CFP · pachymetry 496 µm · 2212 x 1661 pixels · axial length: 24.17 mm · captured on a Topcon TRC-NW400 fundus camera · 60 years old · refraction: +0.25 -1.5 x 160.
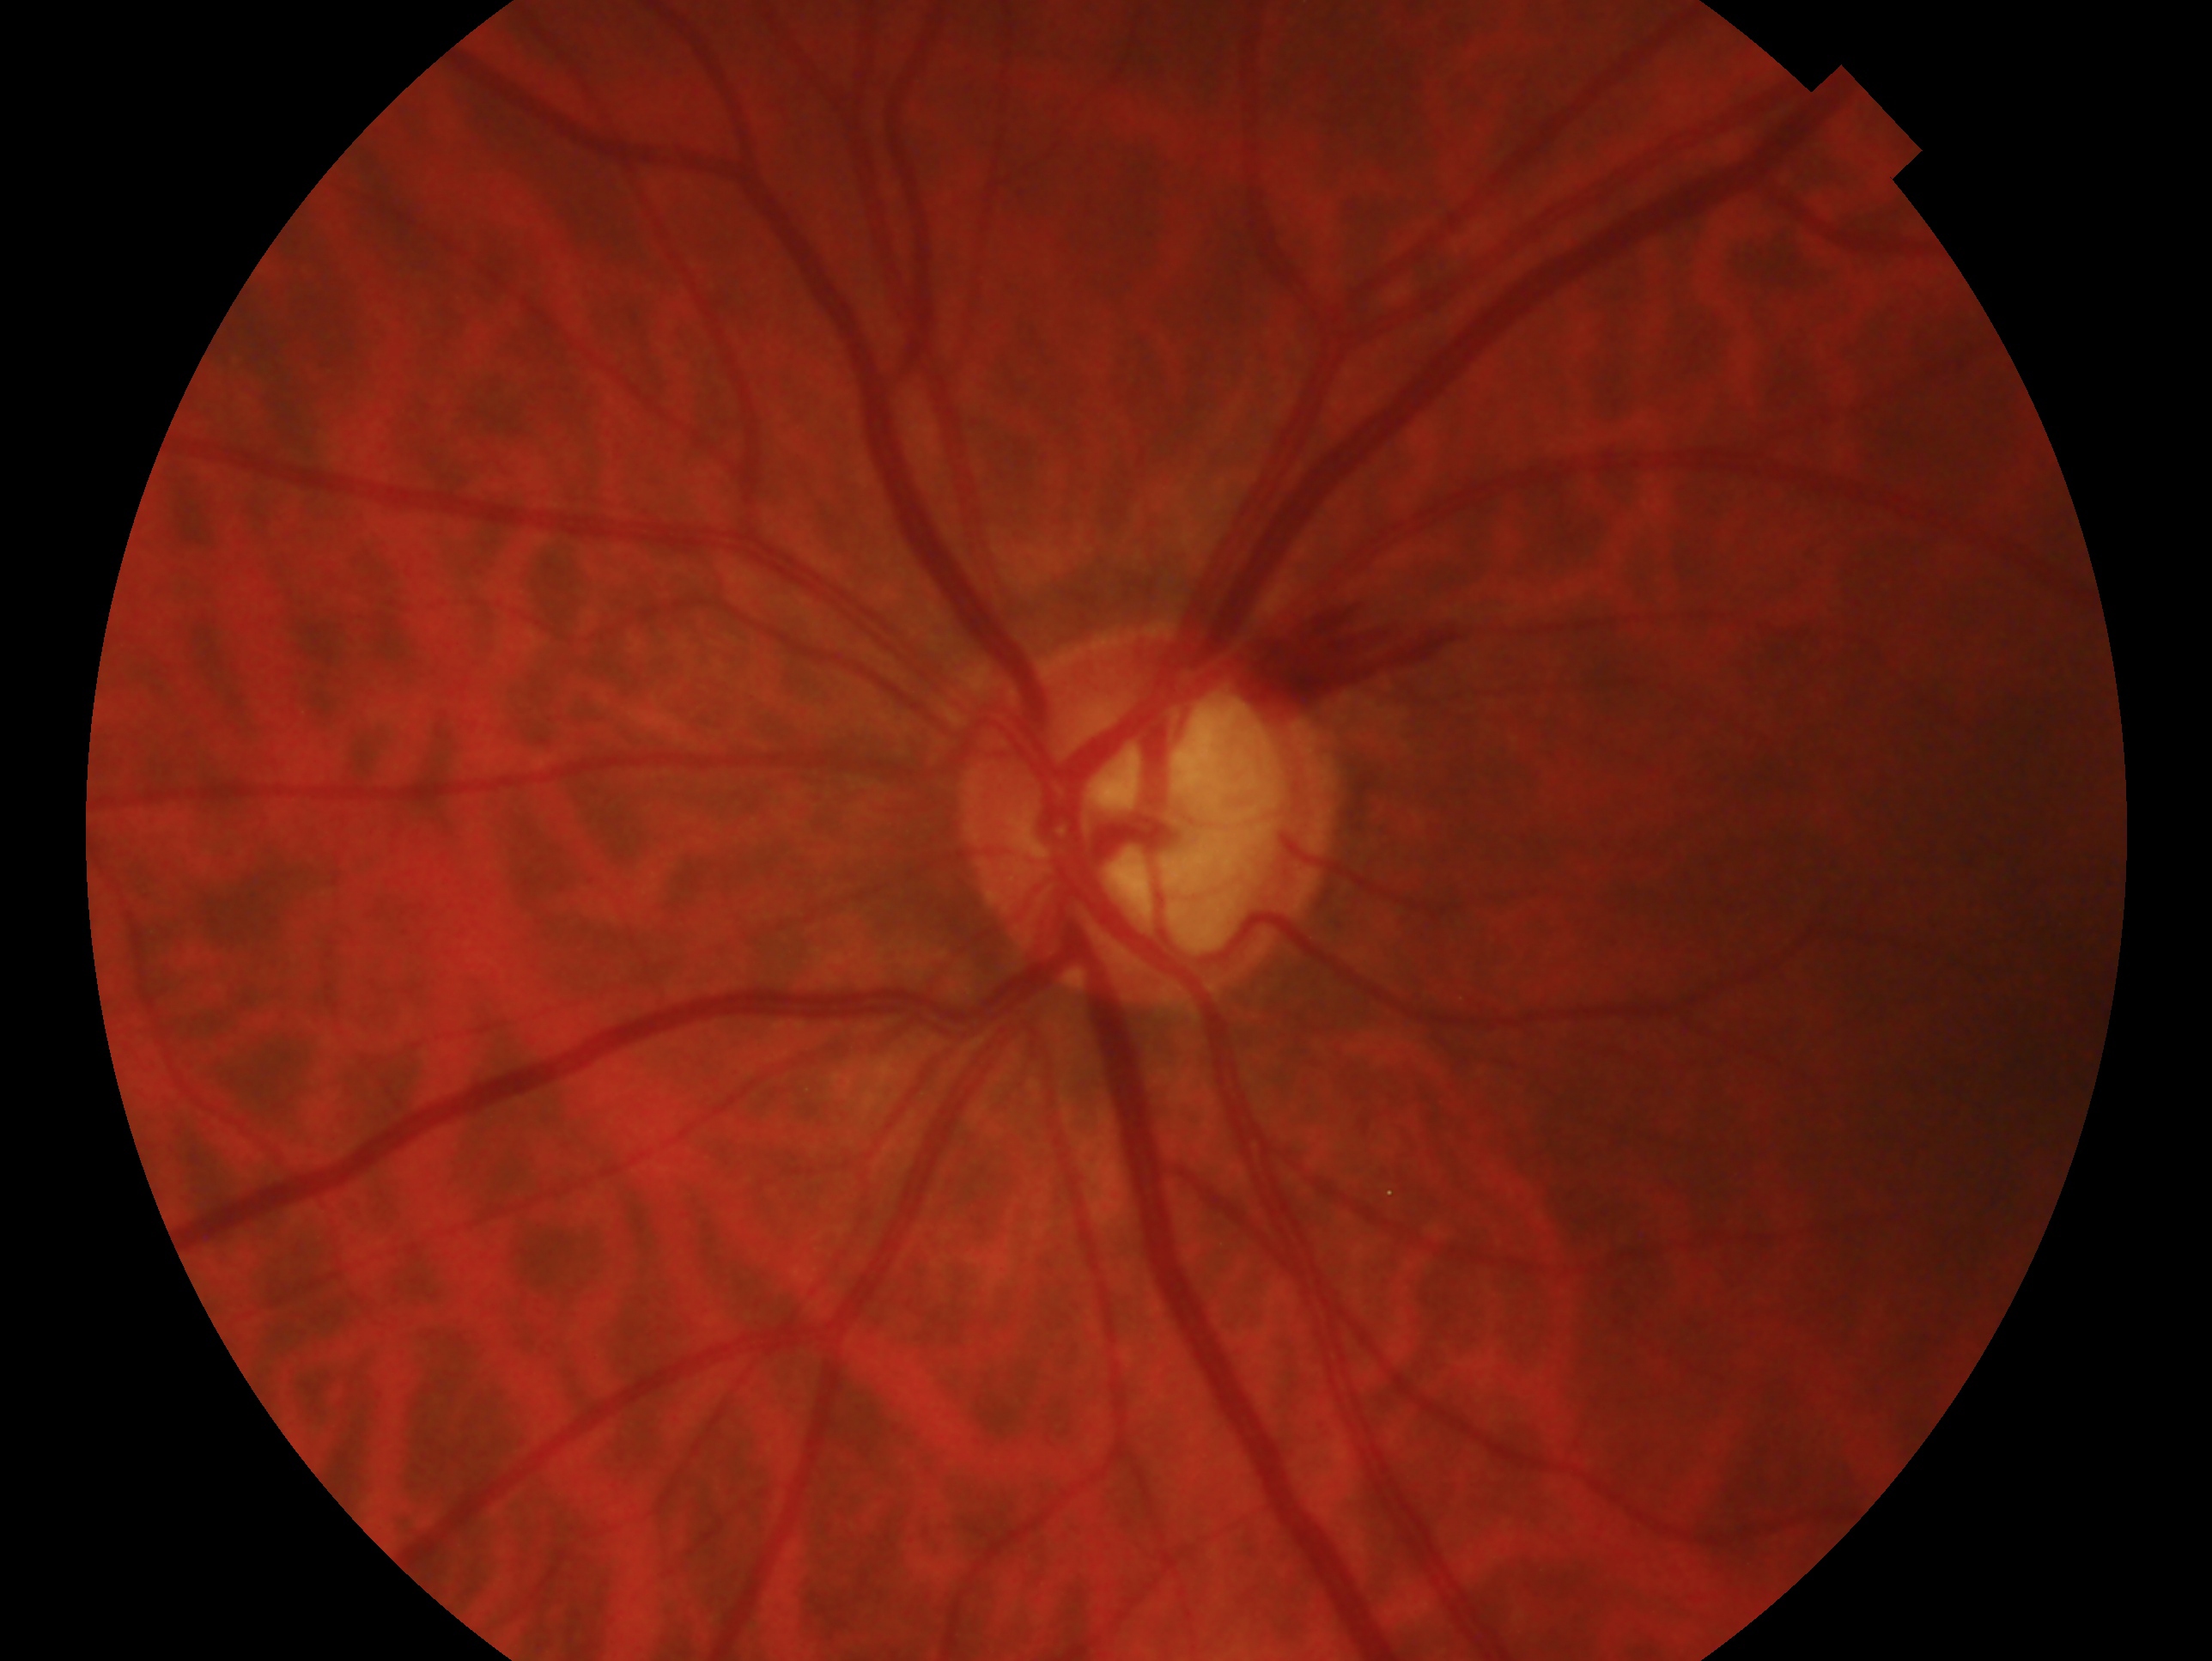 impression=glaucoma; laterality=left eye.